NIDEK AFC-230 fundus camera; fundus photo; 848 by 848 pixels; 45 degree fundus photograph:
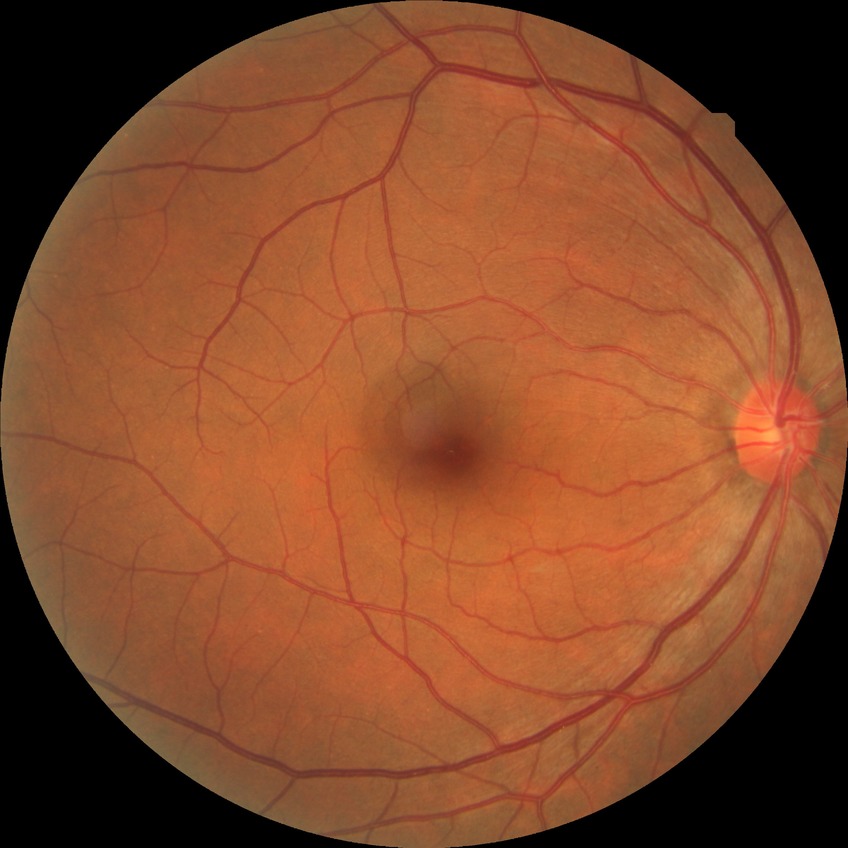 Assessment:
• diabetic retinopathy (DR) — no diabetic retinopathy (NDR)